Wide-field fundus photograph from neonatal ROP screening: 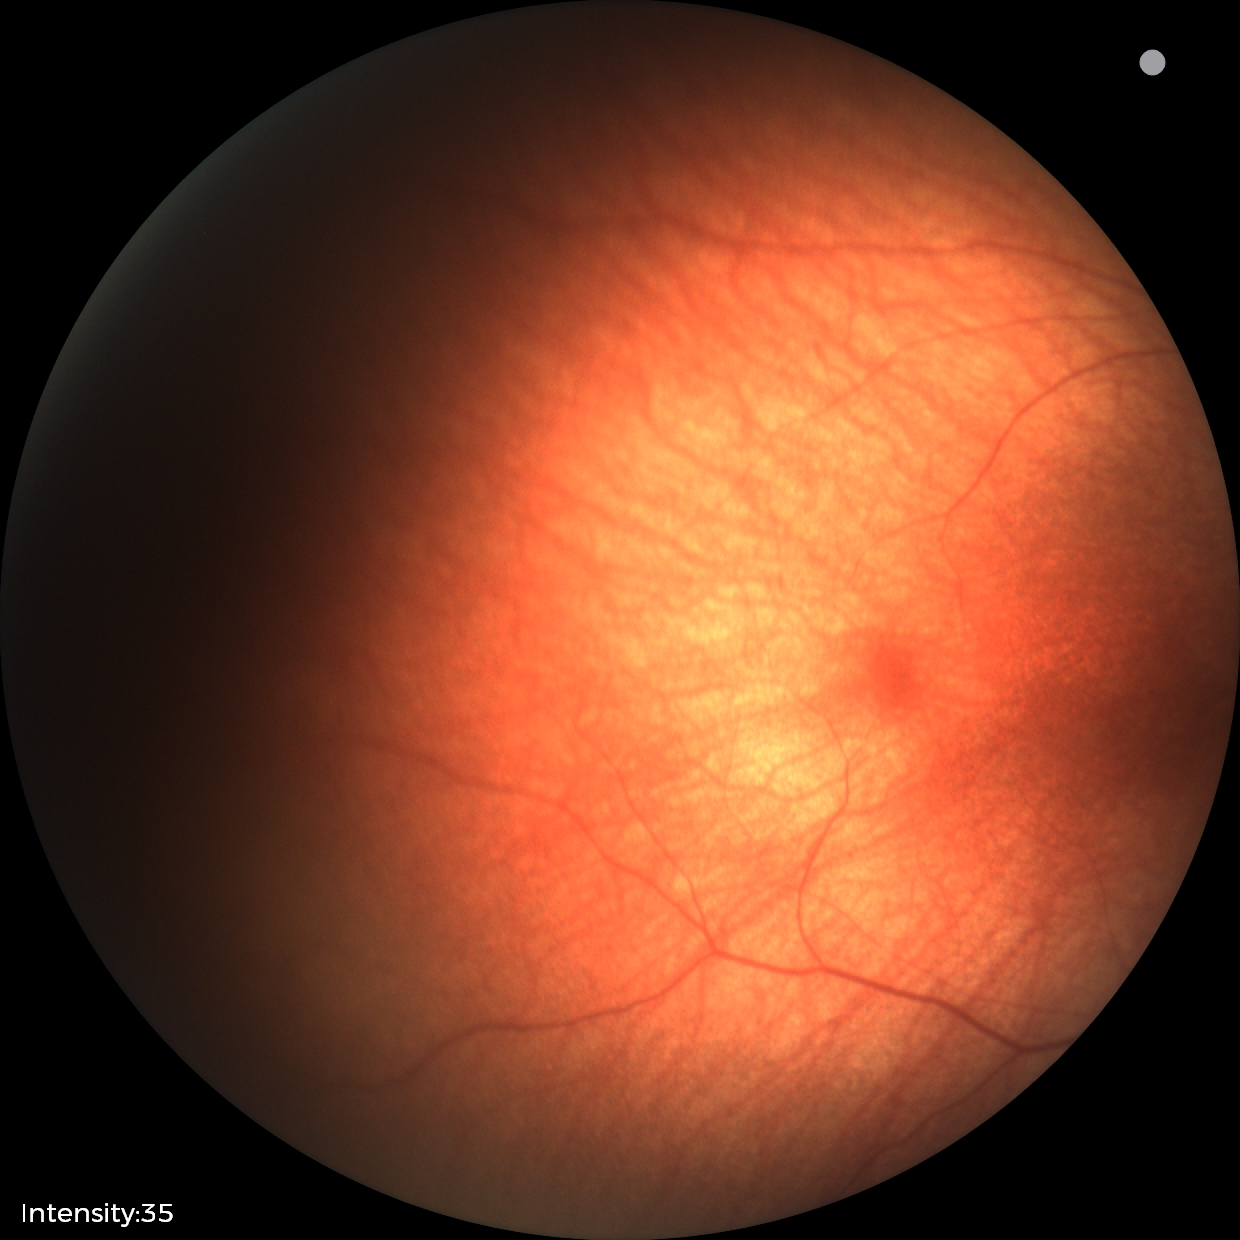
Screening examination diagnosed as physiological.